45° field of view, retinal fundus photograph — 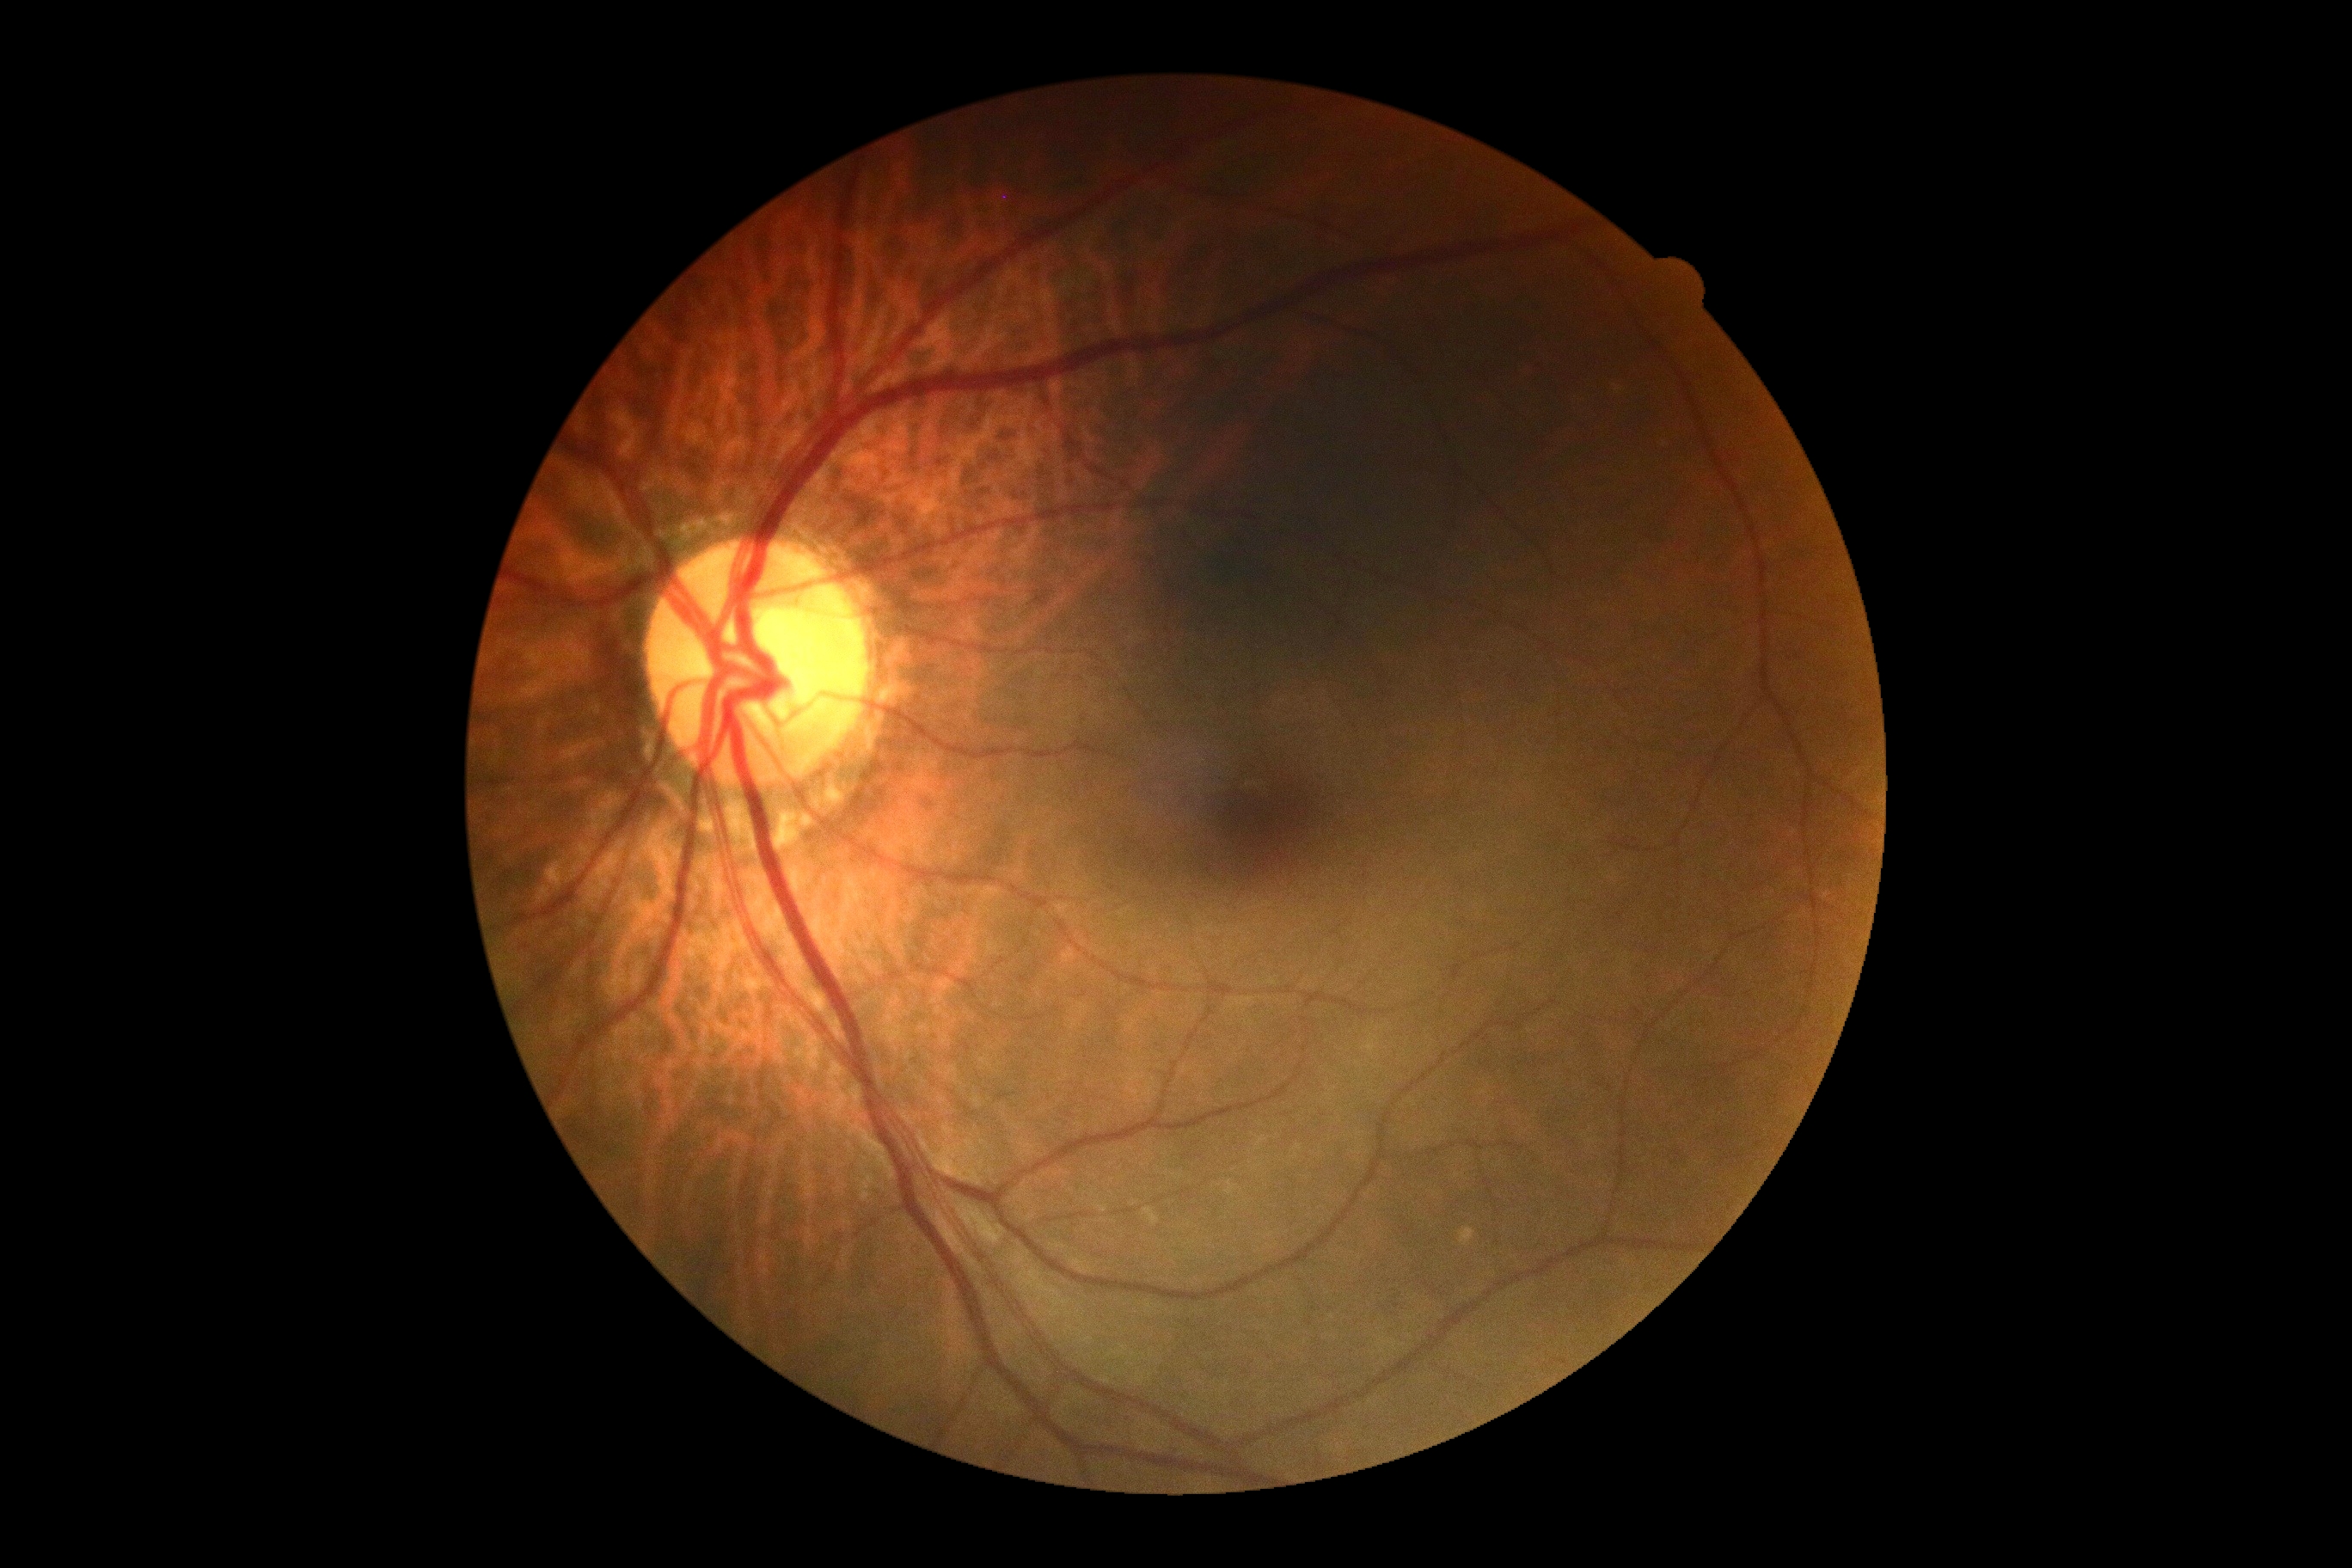 Findings:
– DR: no apparent diabetic retinopathy (grade 0)